1240 x 1240 pixels. Infant wide-field retinal image. Phoenix ICON, 100° FOV: 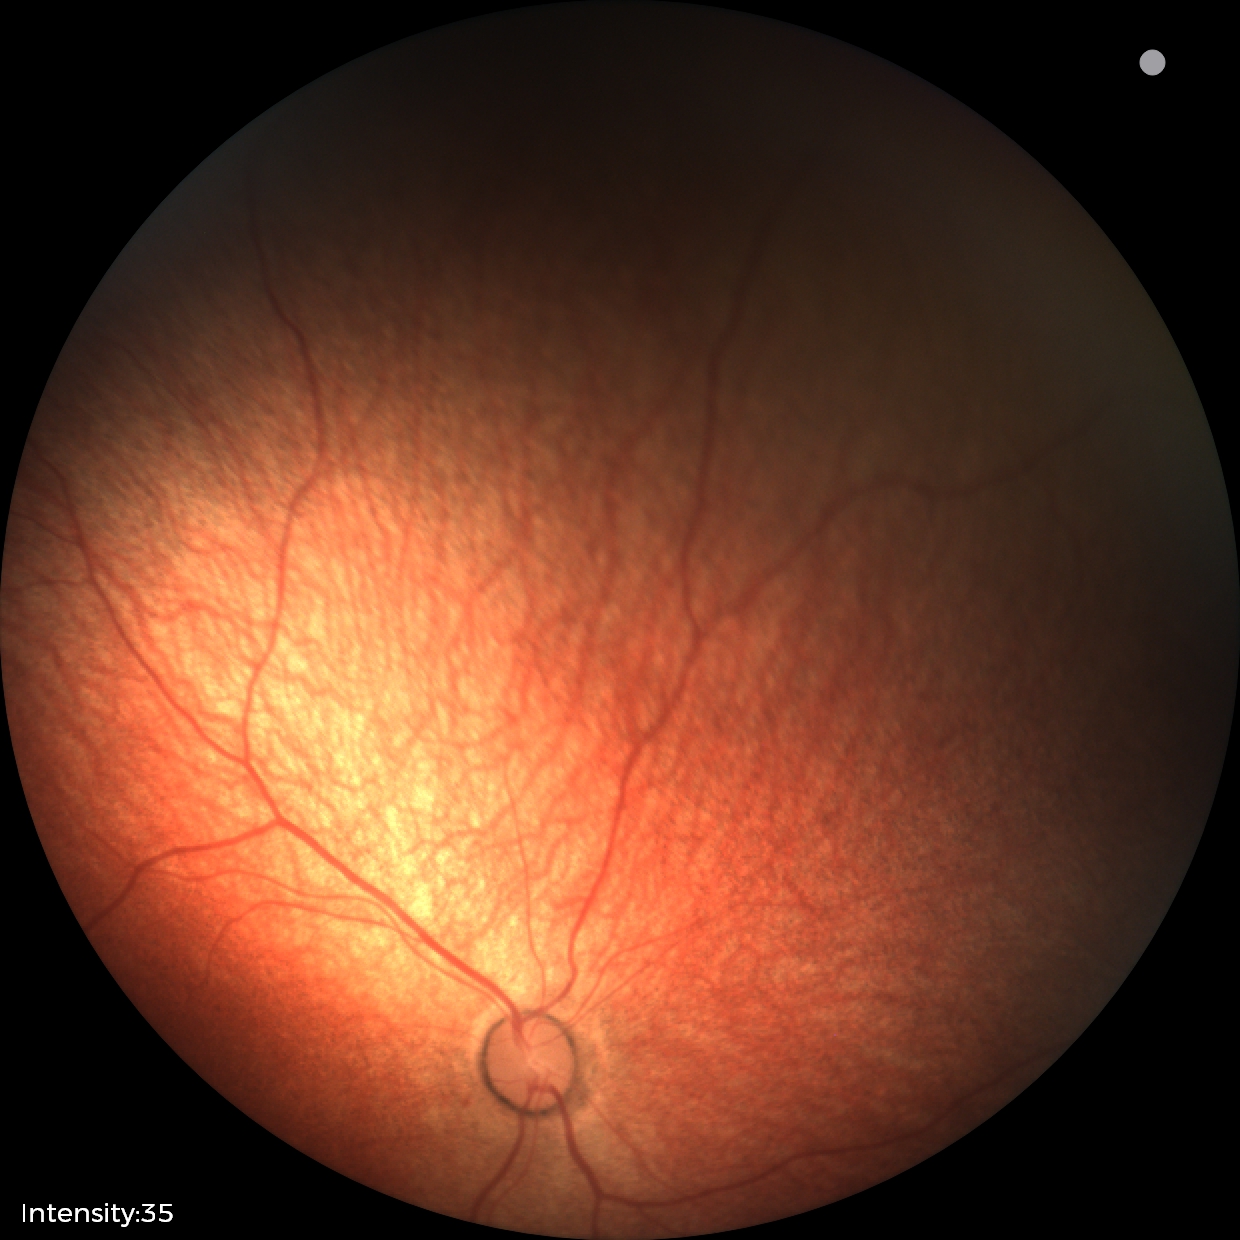
Screening examination diagnosed as physiological.